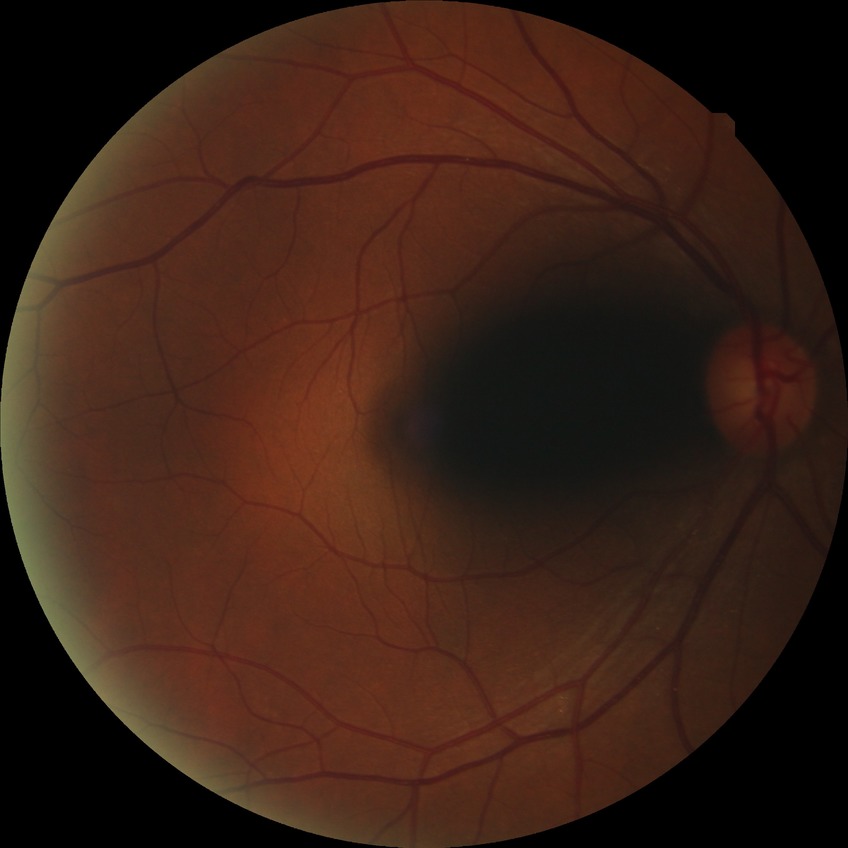

{"davis_grade": "no diabetic retinopathy (NDR)"}